Wide-field fundus photograph from neonatal ROP screening; 1240 x 1240 pixels; camera: Phoenix ICON (100° FOV).
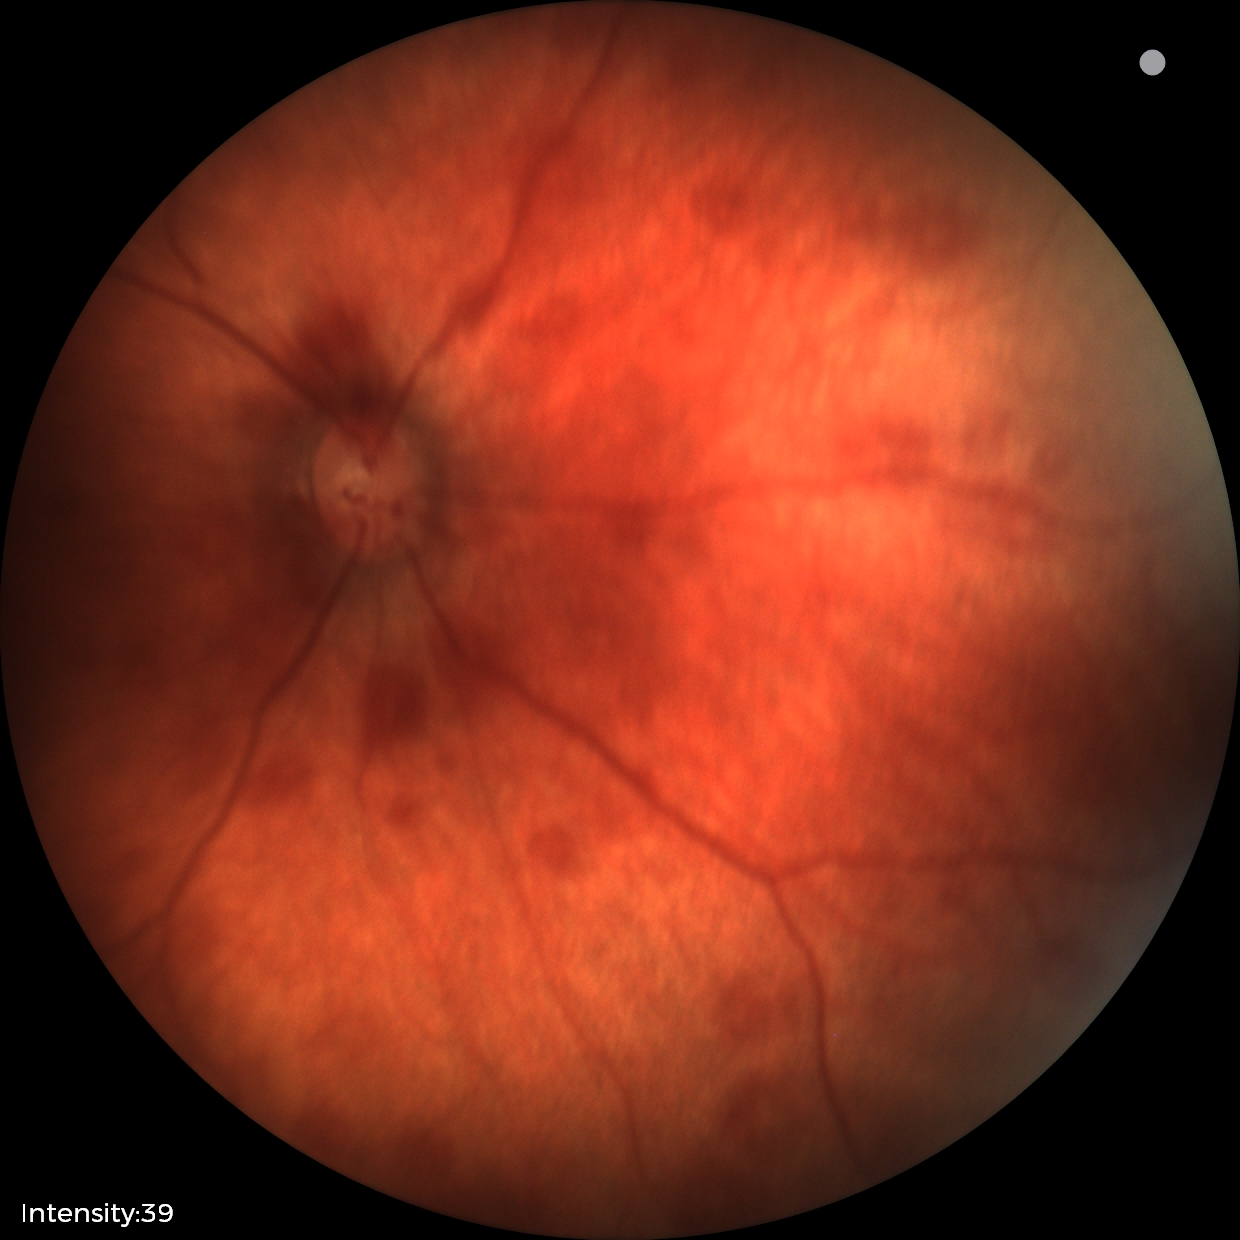

Q: What is the screening diagnosis?
A: retinal hemorrhages